Wide-field fundus photograph of an infant · Natus RetCam Envision, 130° FOV: 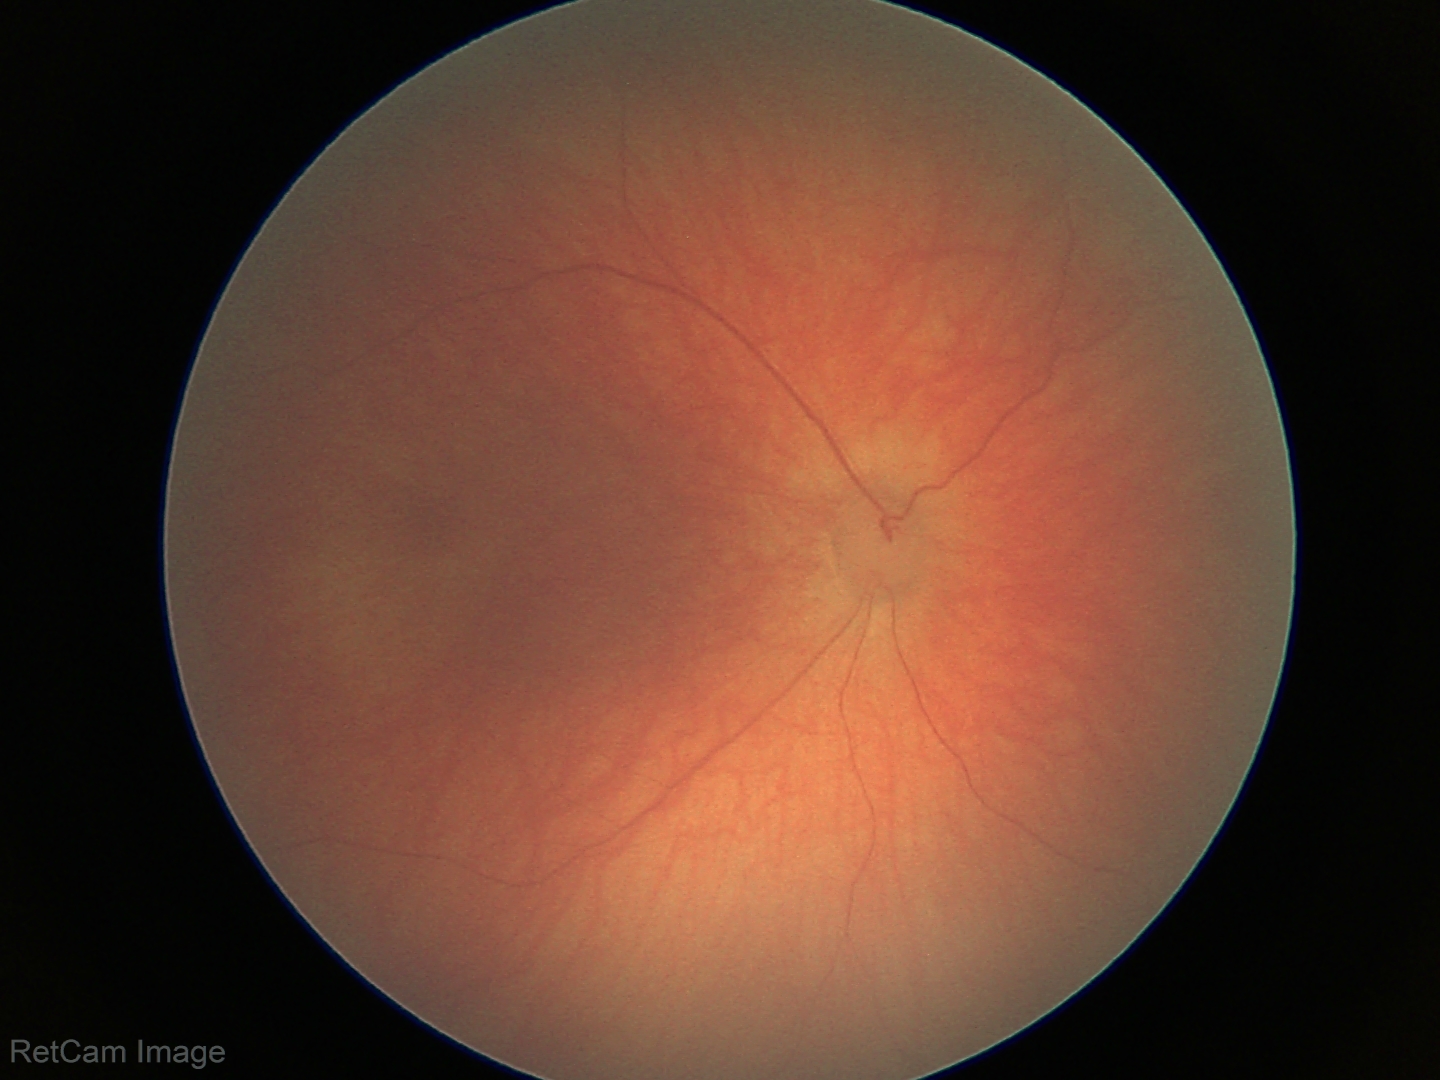
Screening diagnosis: normal